45° field of view · 2352 by 1568 pixels
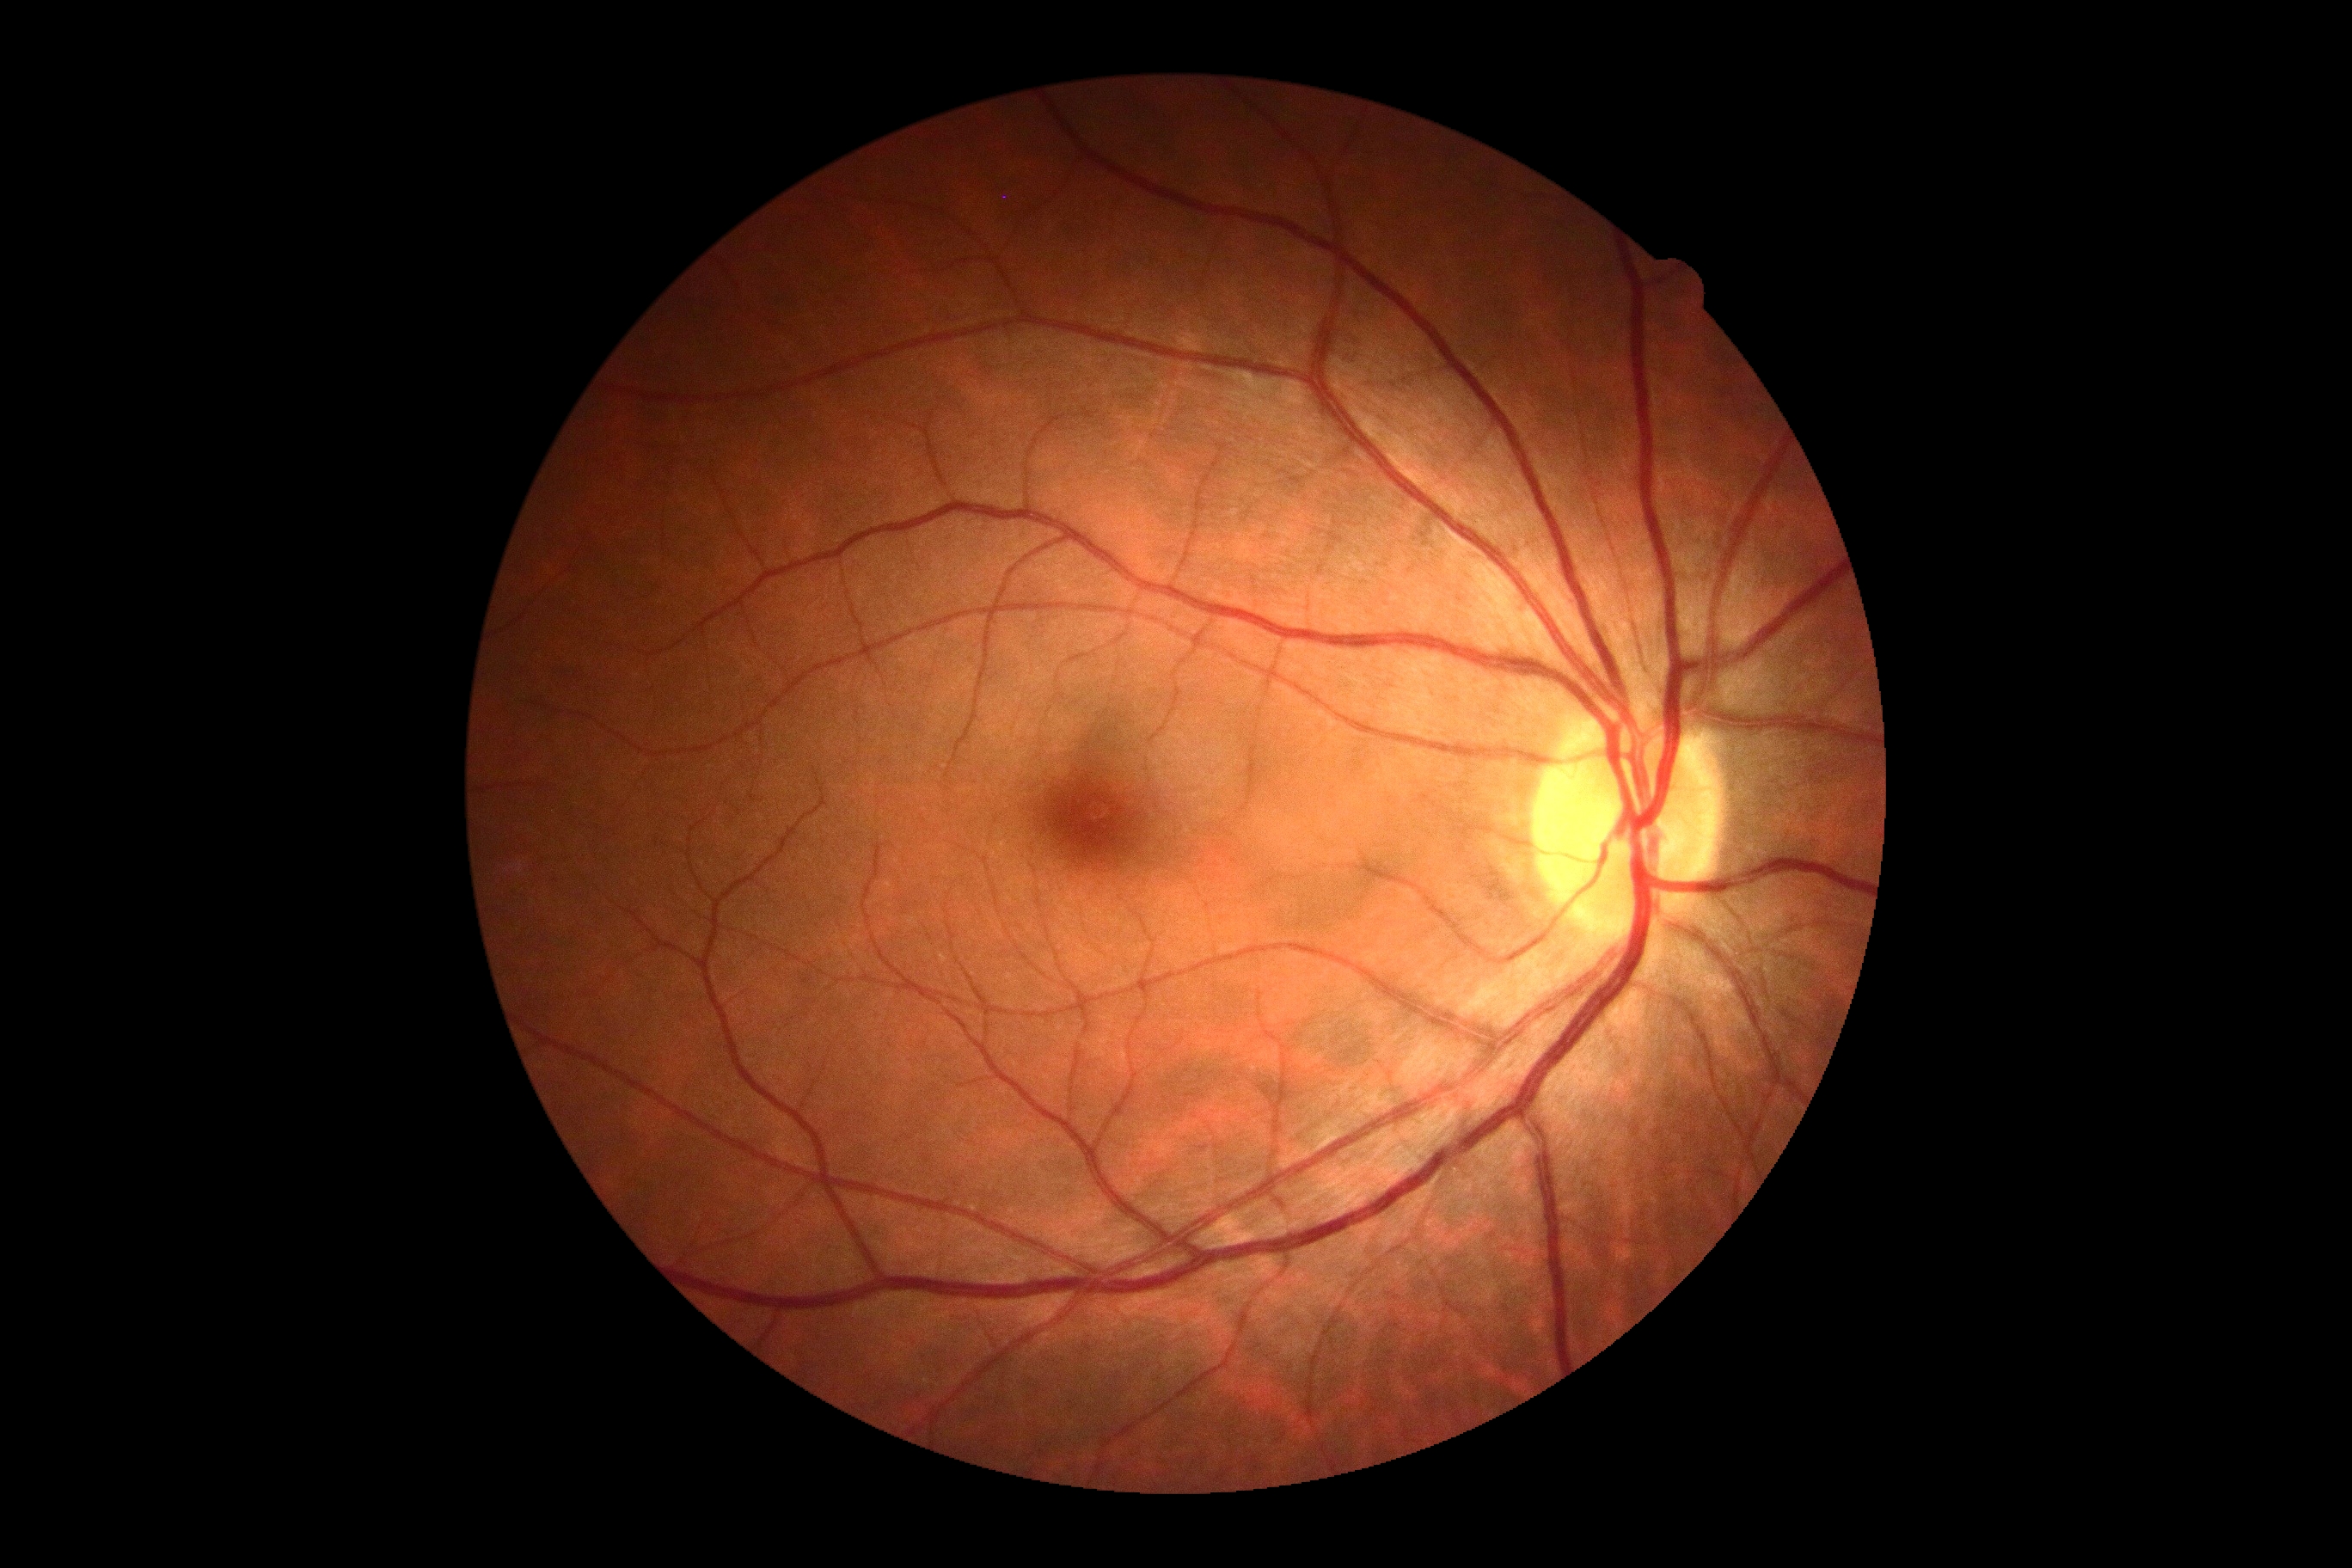
diabetic retinopathy (DR): 0.